Retinal fundus photograph. FOV: 30 degrees. Undilated pupil:
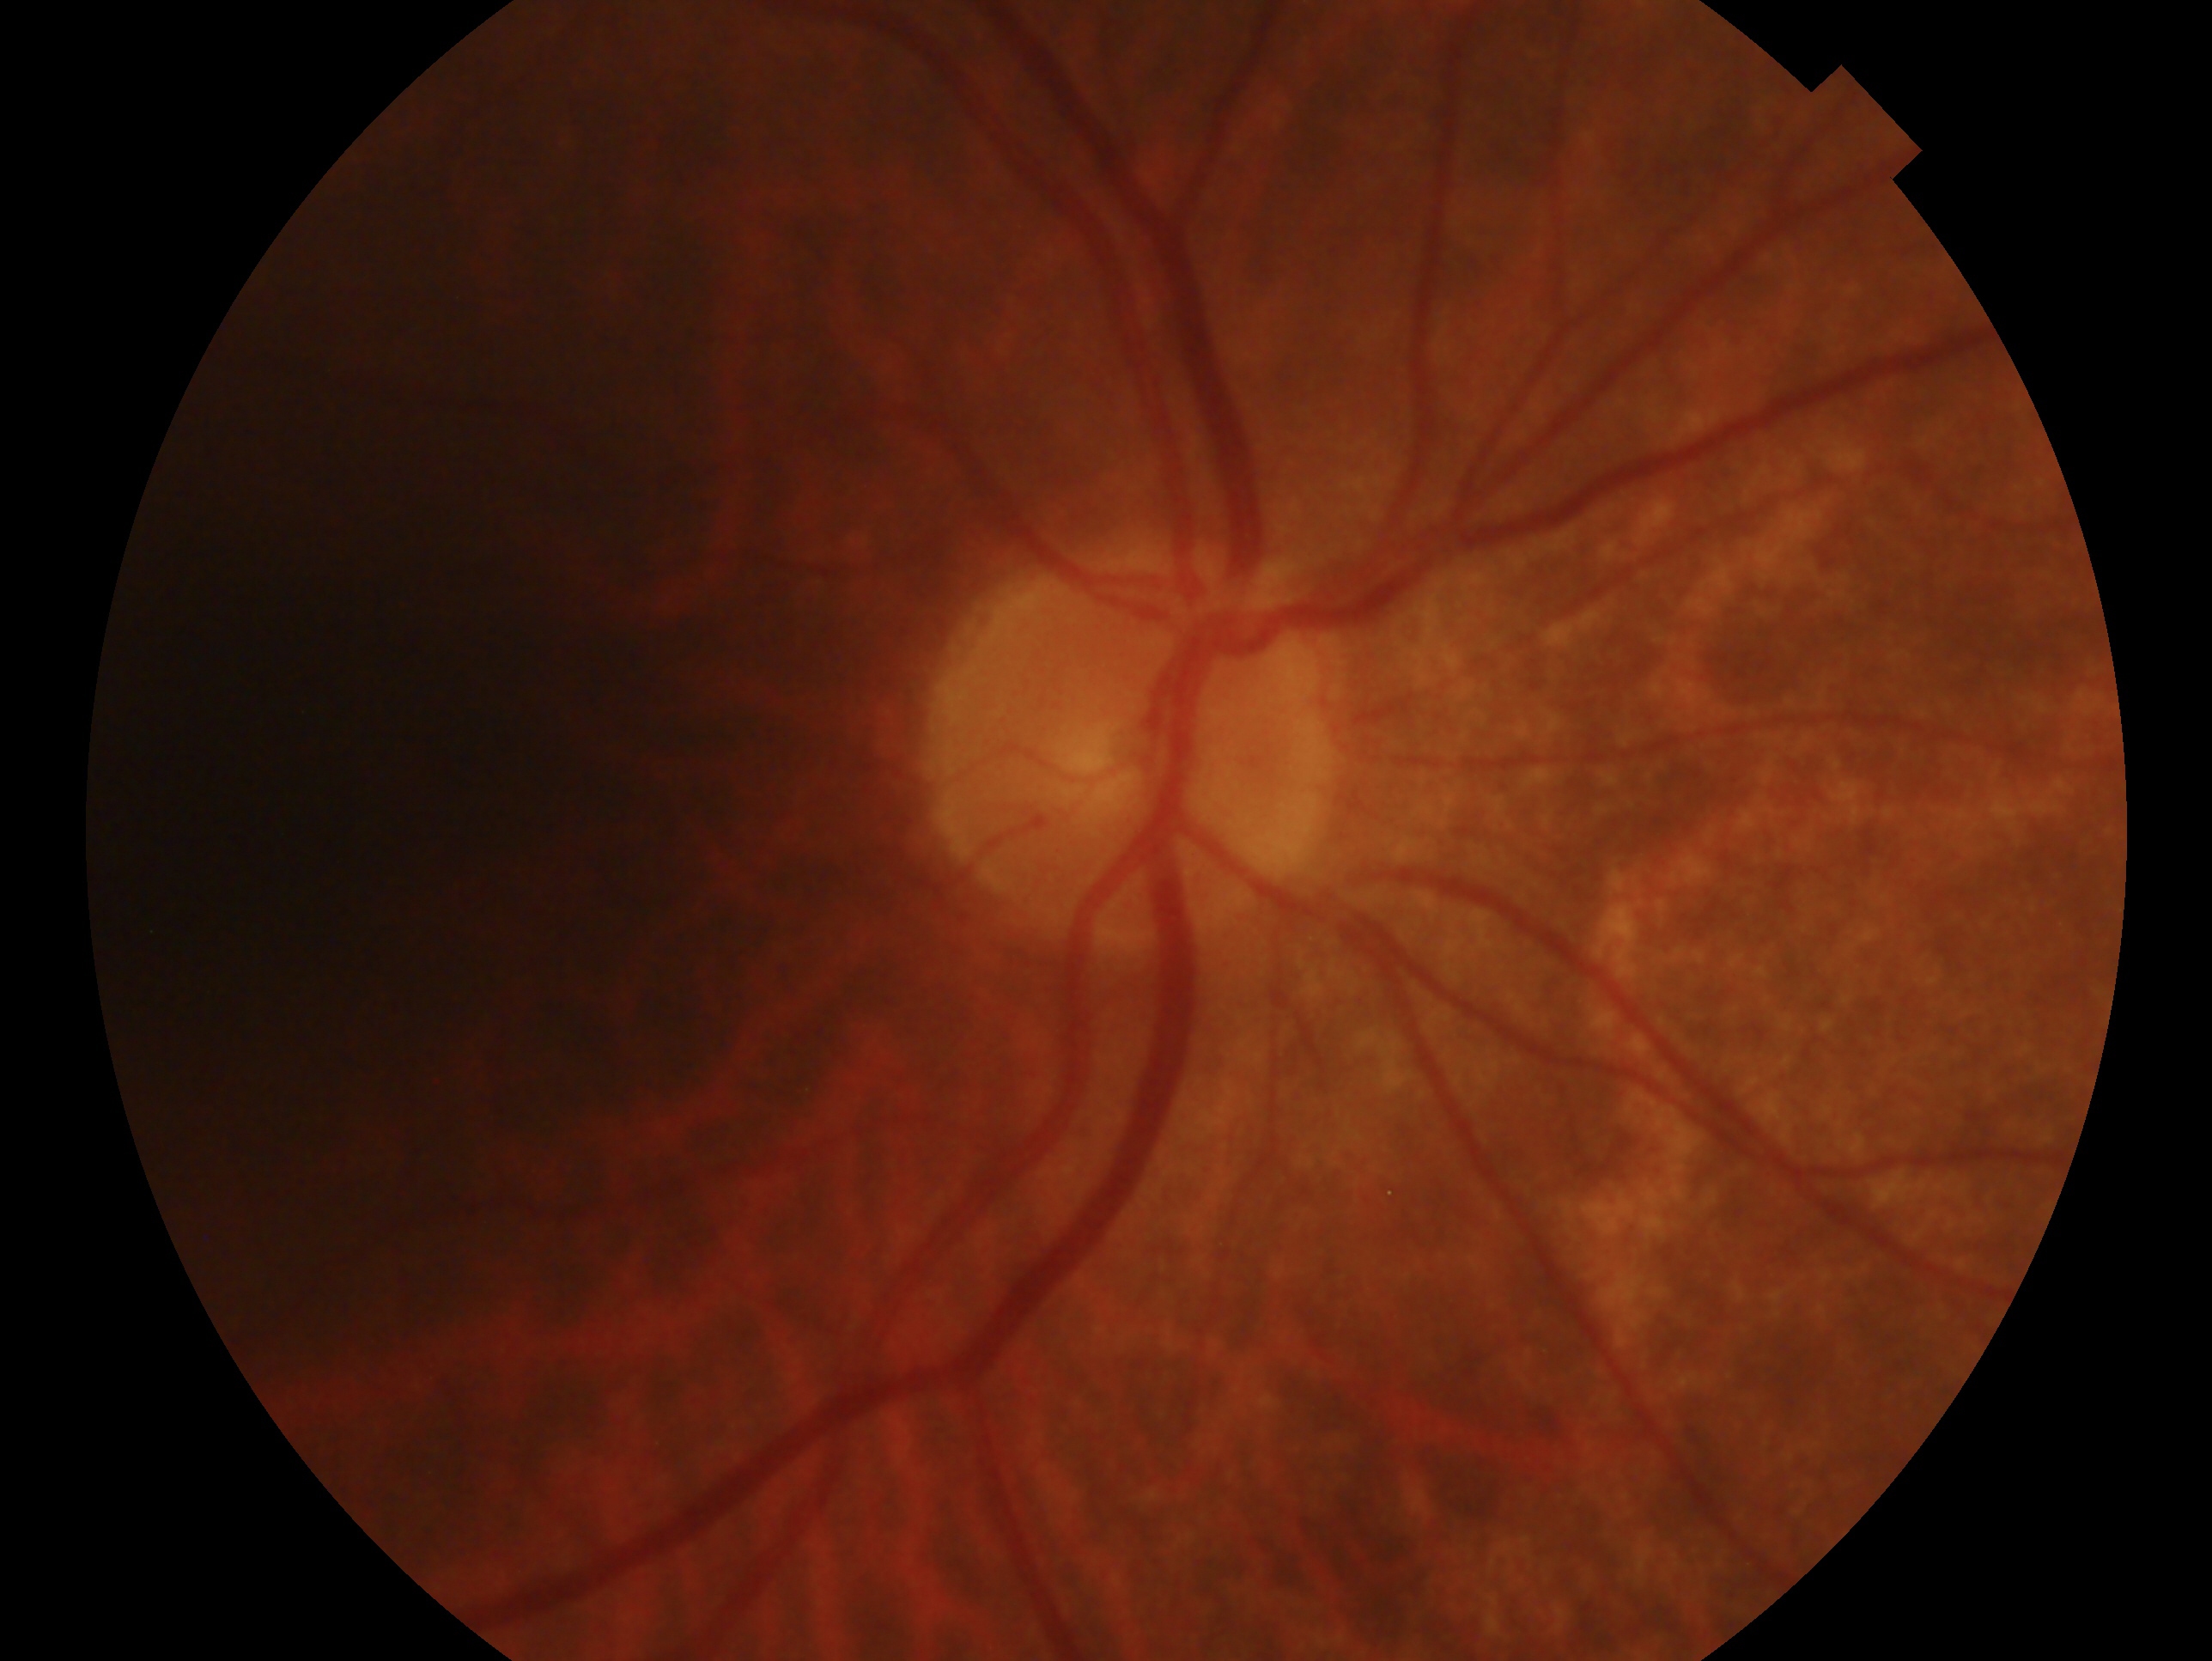 laterality = right eye
diagnosis = no signs of glaucoma — no clinical evidence of glaucoma in this eye